2352x1568, FOV: 45 degrees — 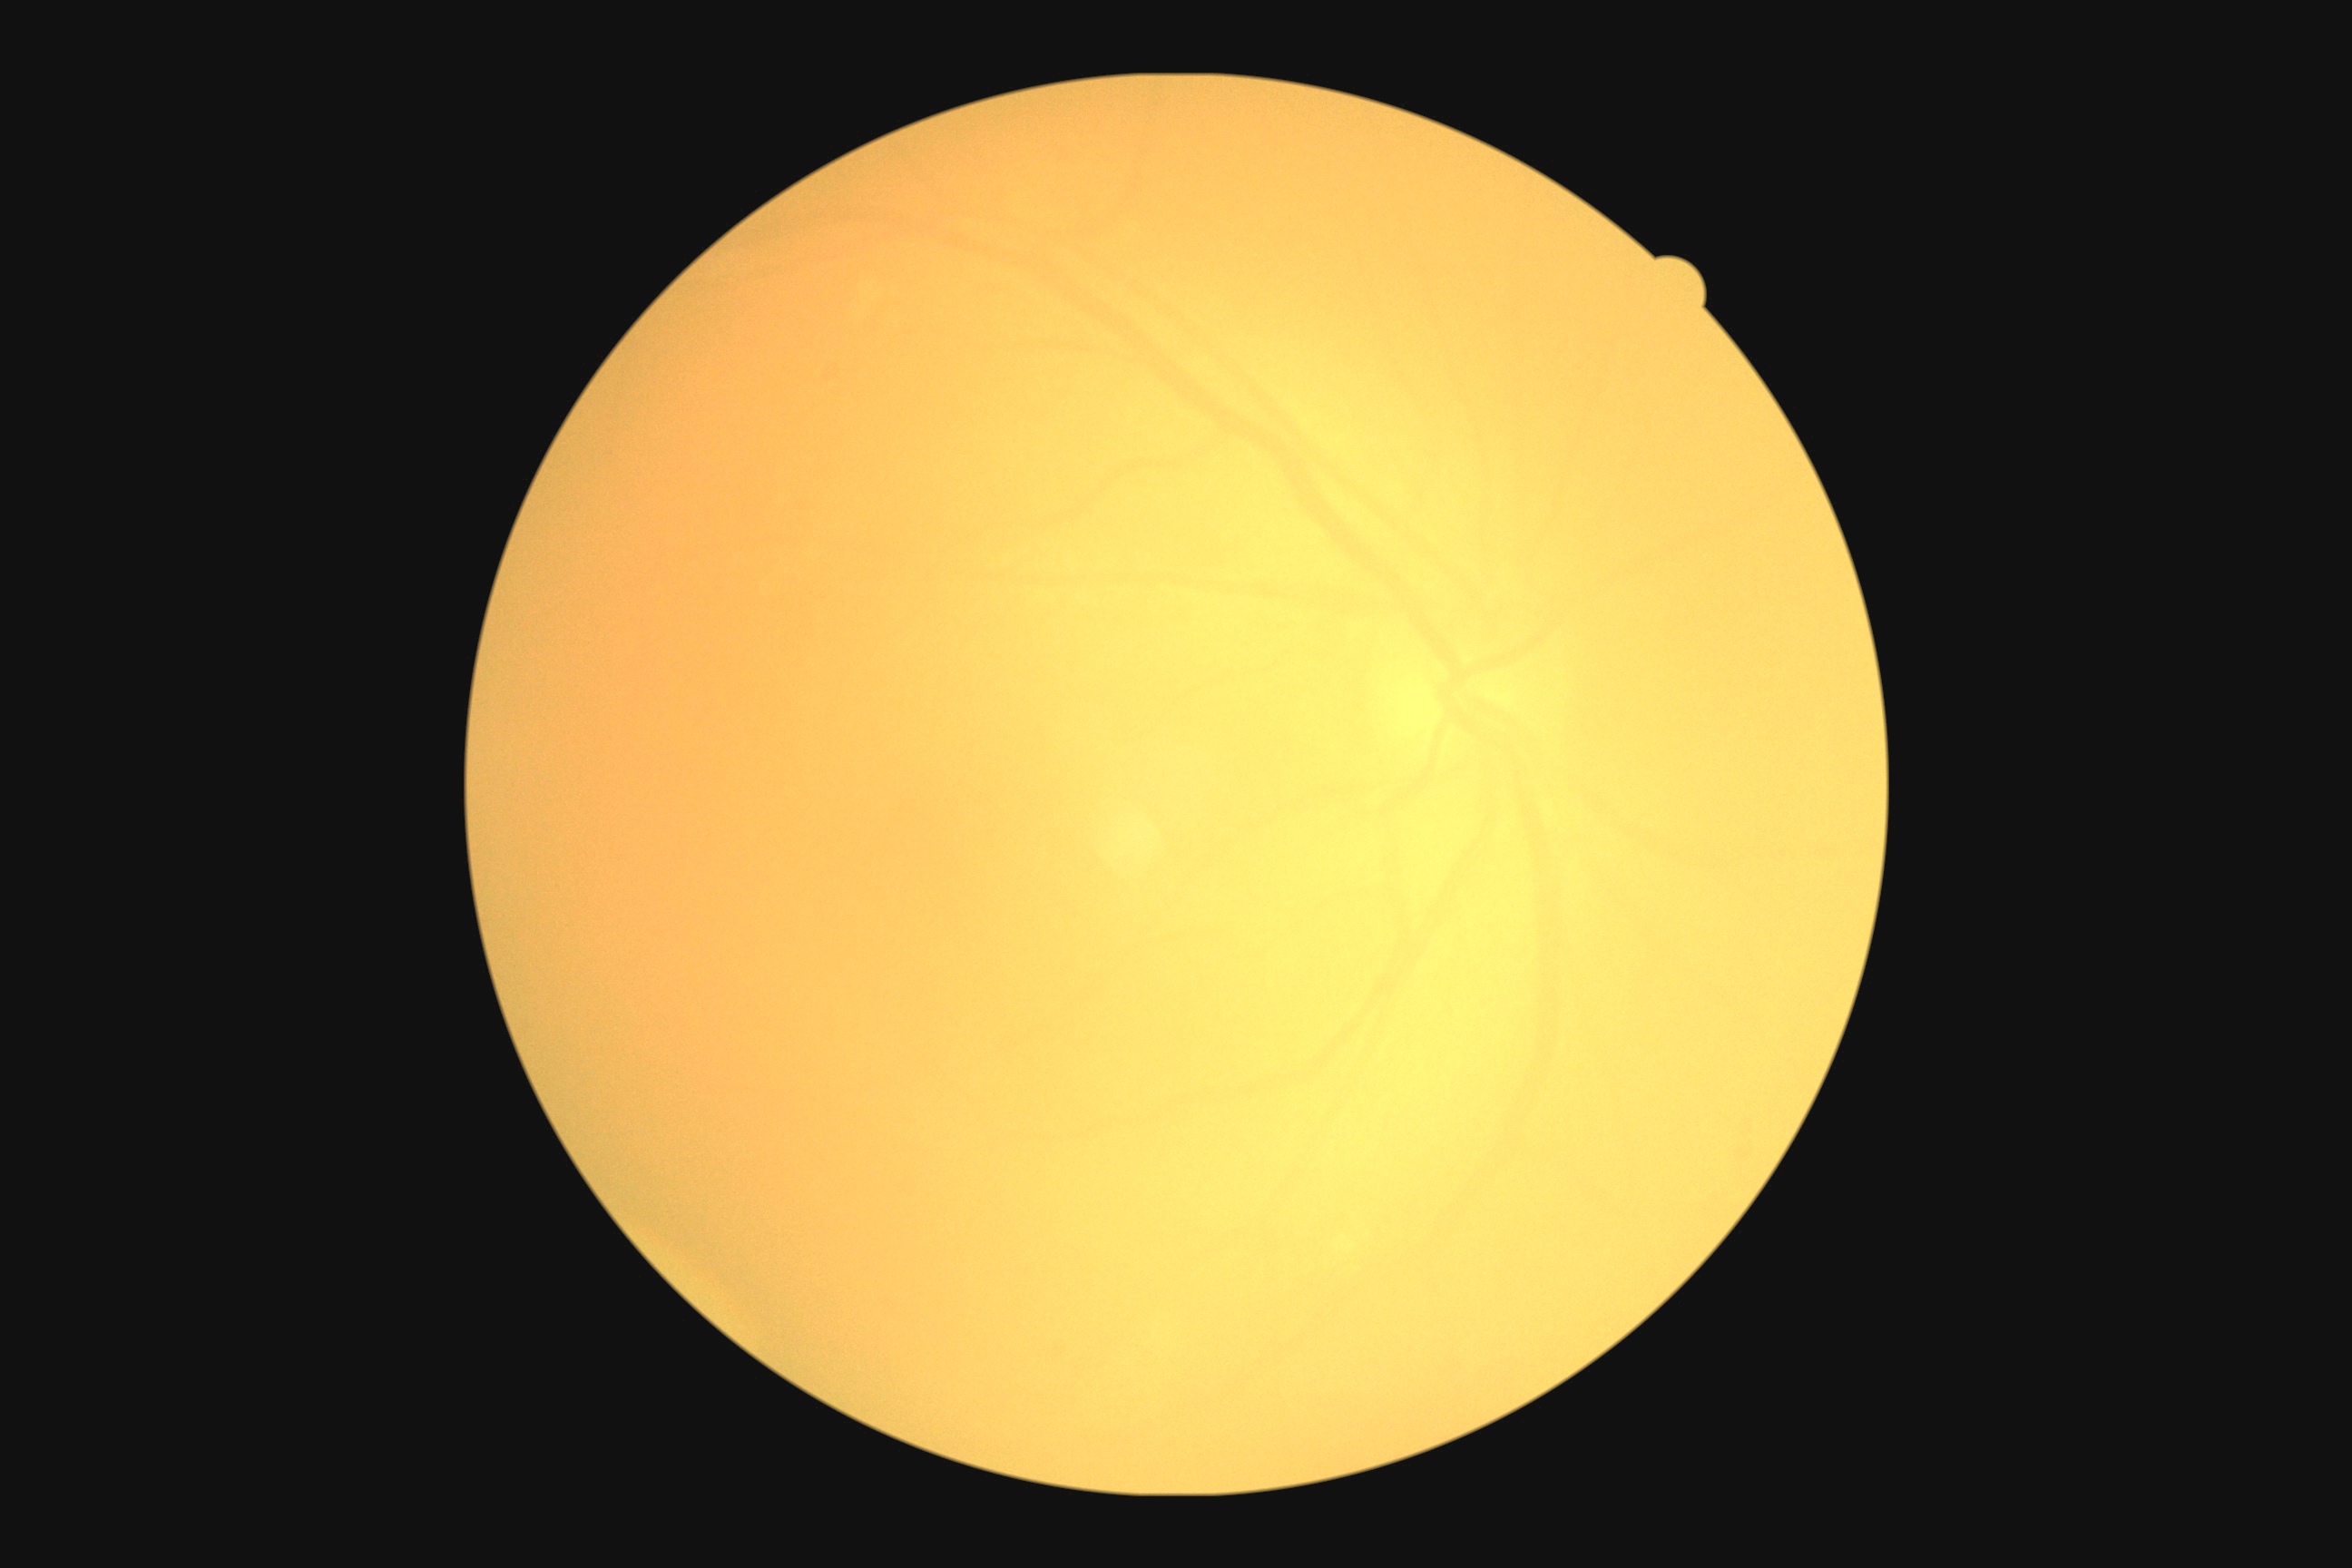

{"dr_grade": "ungradable", "quality": "insufficient for DR assessment"}